45° FOV; 2352 x 1568 pixels; retinal fundus photograph:
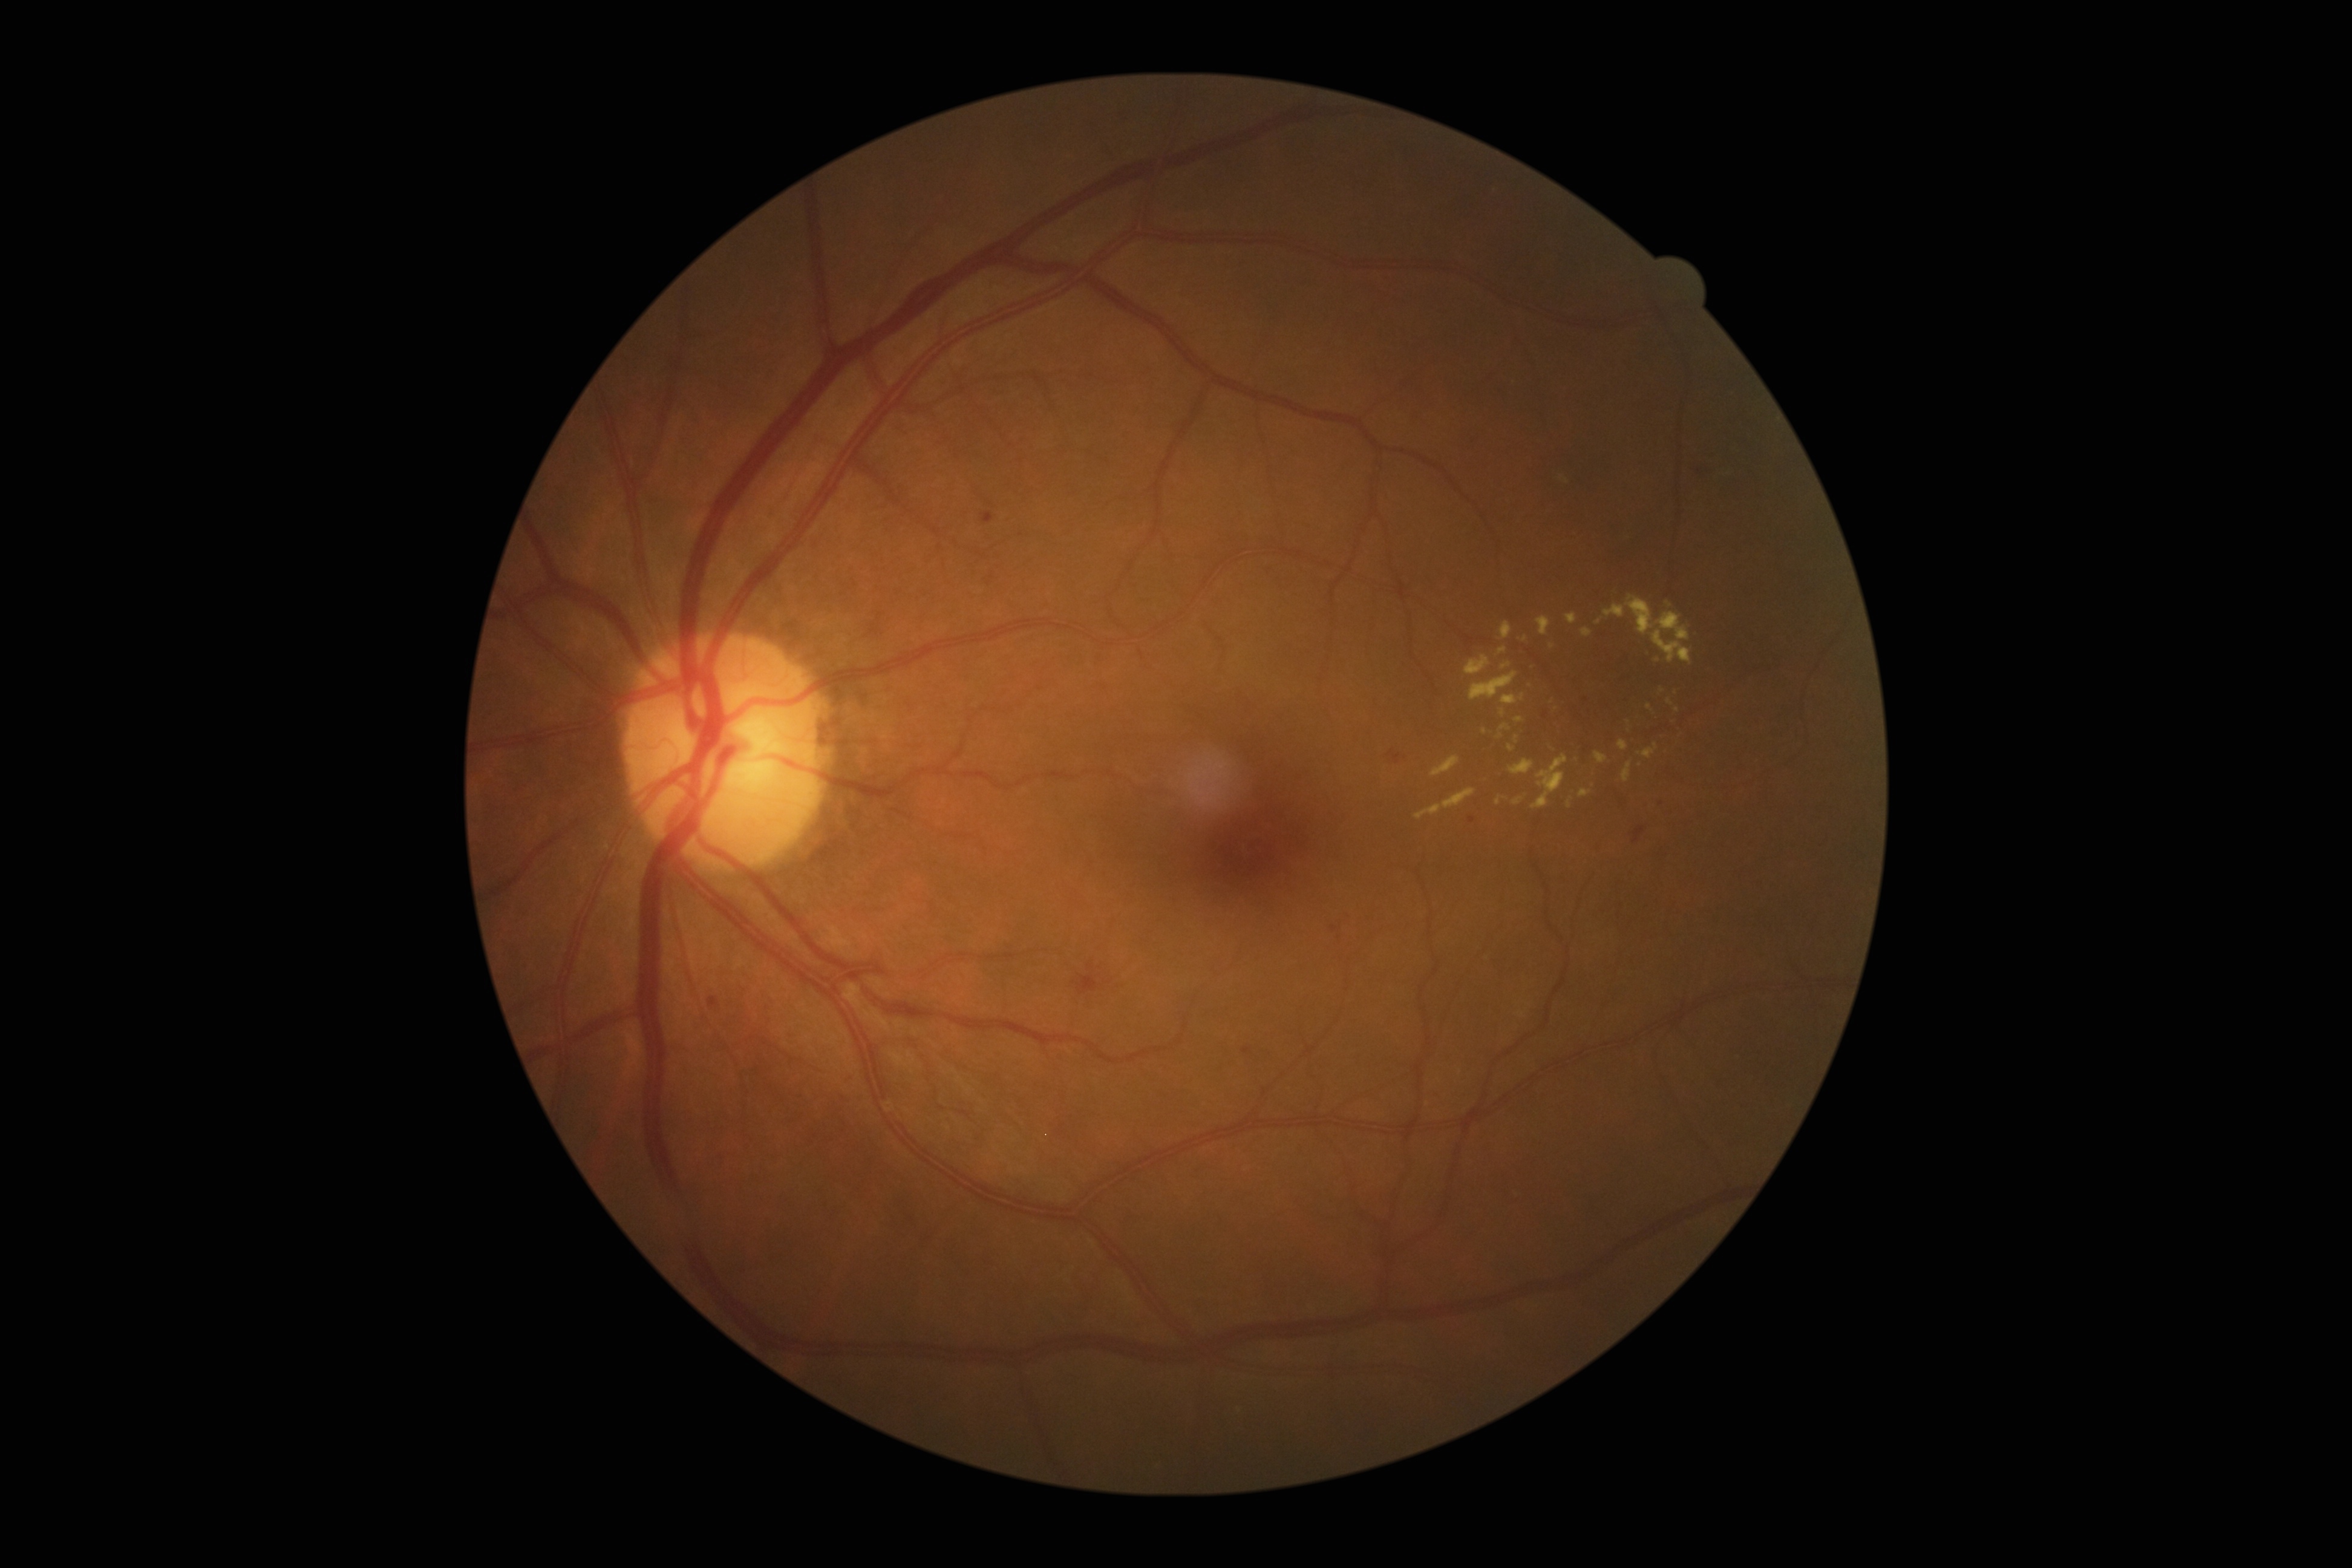

Diabetic retinopathy severity is moderate non-proliferative diabetic retinopathy (grade 2).